45-degree field of view, posterior pole photograph, diabetic retinopathy graded by the modified Davis classification.
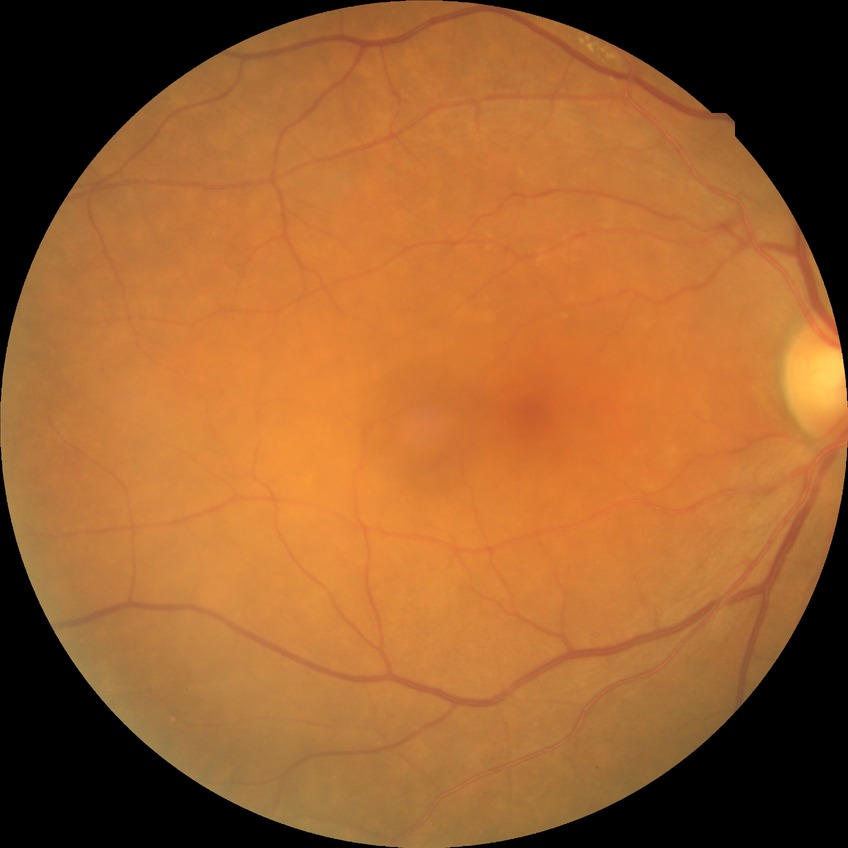 Retinopathy stage: simple diabetic retinopathy.